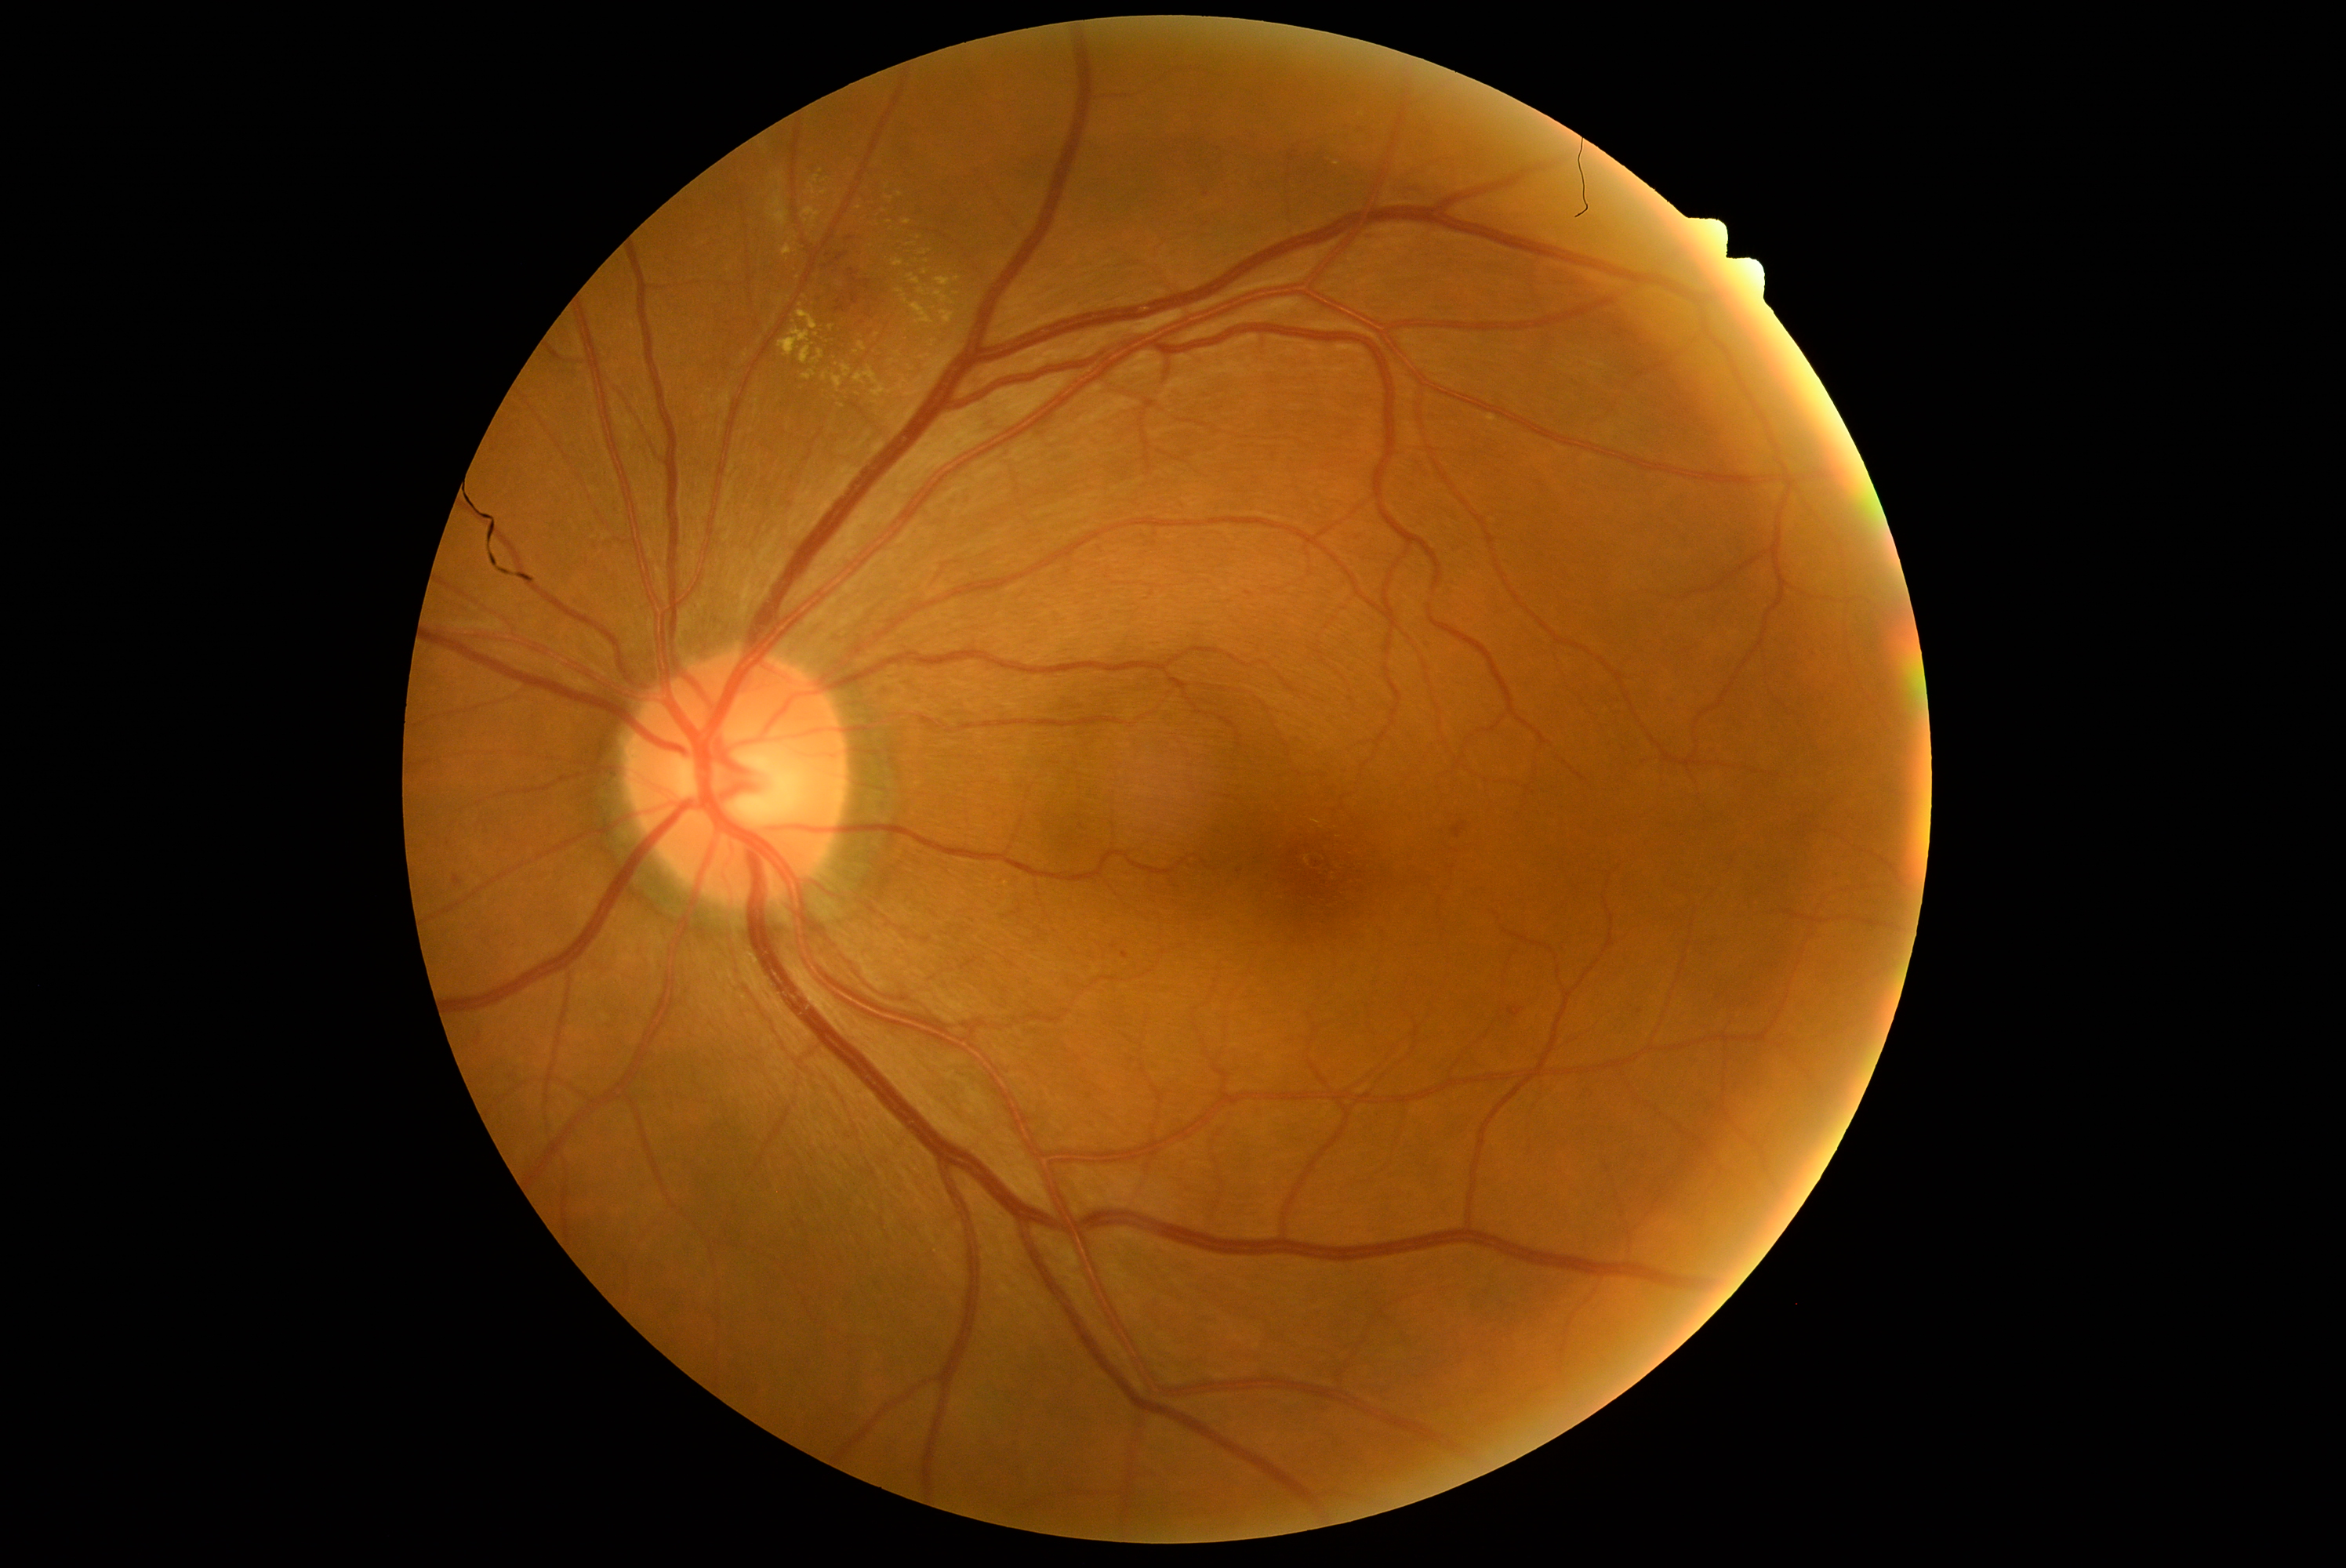
DR grade is moderate NPDR (2)
Selected lesions:
EXs (subset) = (left=859, top=343, right=866, bottom=352), (left=832, top=376, right=843, bottom=391), (left=783, top=245, right=793, bottom=256), (left=802, top=371, right=816, bottom=380), (left=907, top=365, right=915, bottom=372), (left=744, top=352, right=750, bottom=360), (left=802, top=206, right=821, bottom=231), (left=902, top=296, right=935, bottom=325), (left=940, top=310, right=954, bottom=327)
Small EXs near [957,279], [875,402], [900,195], [856,352], [782,178], [831,328], [794,237], [890,199]